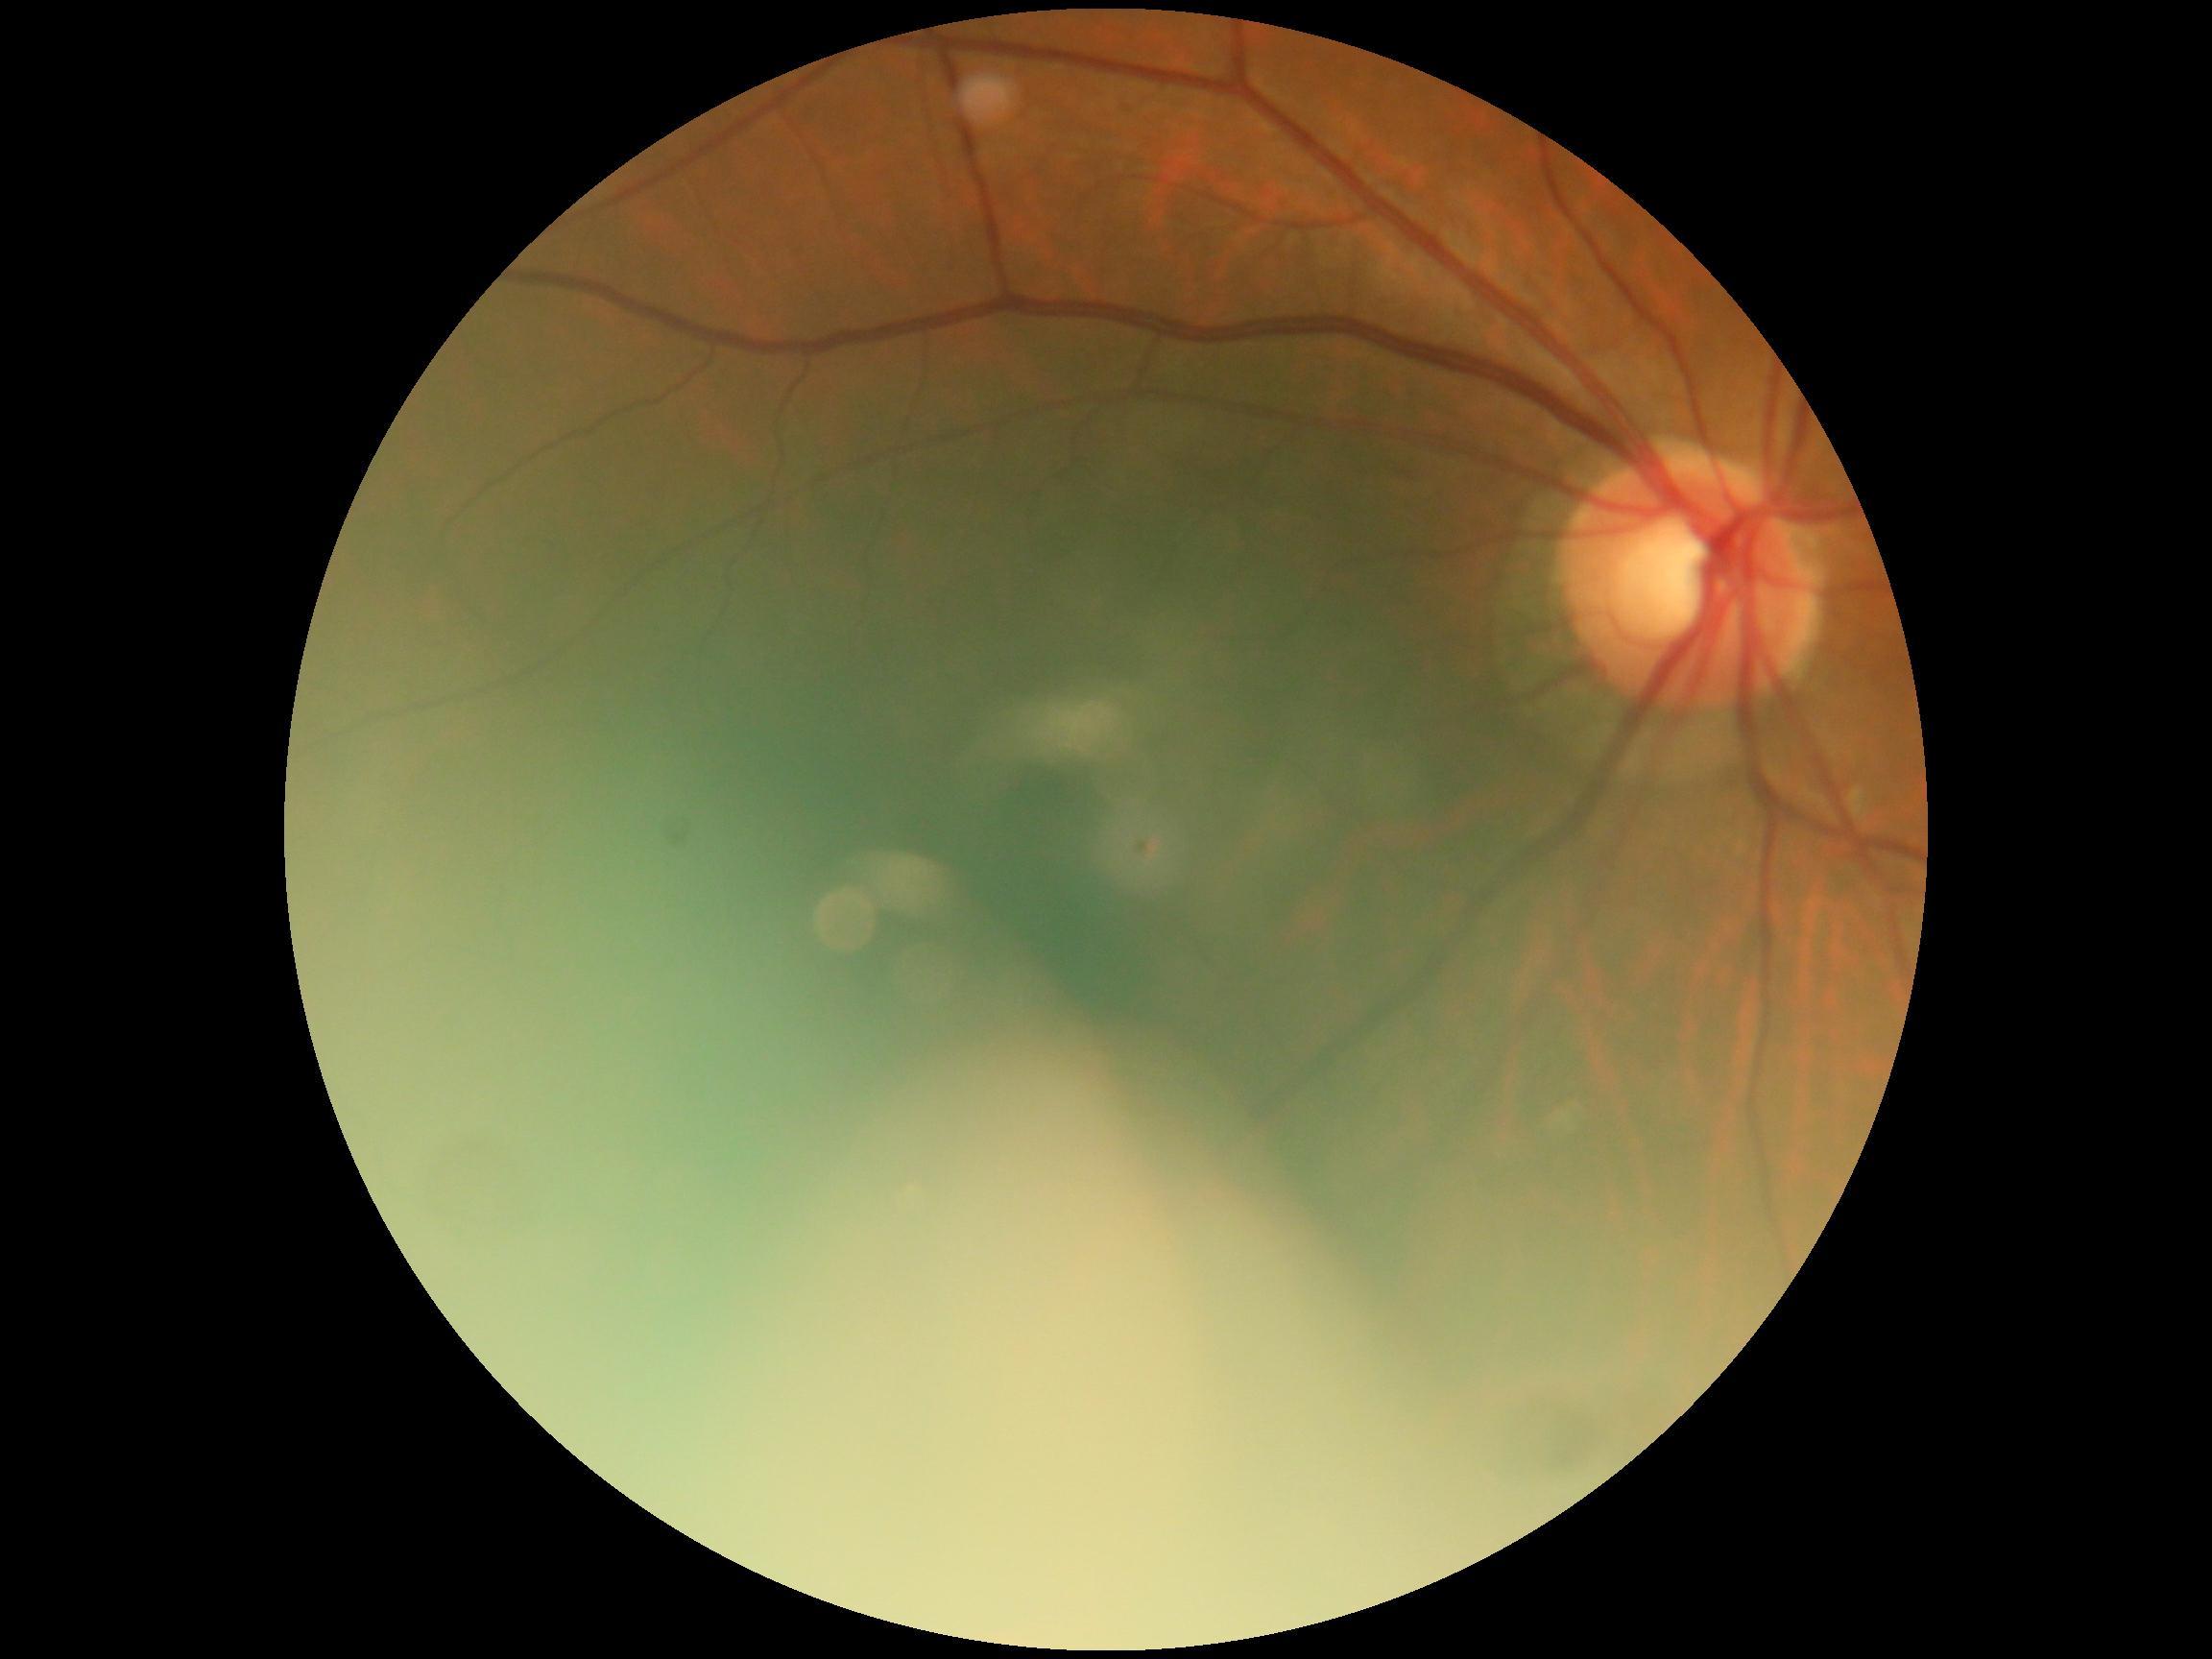

DR severity is no apparent diabetic retinopathy (grade 0).